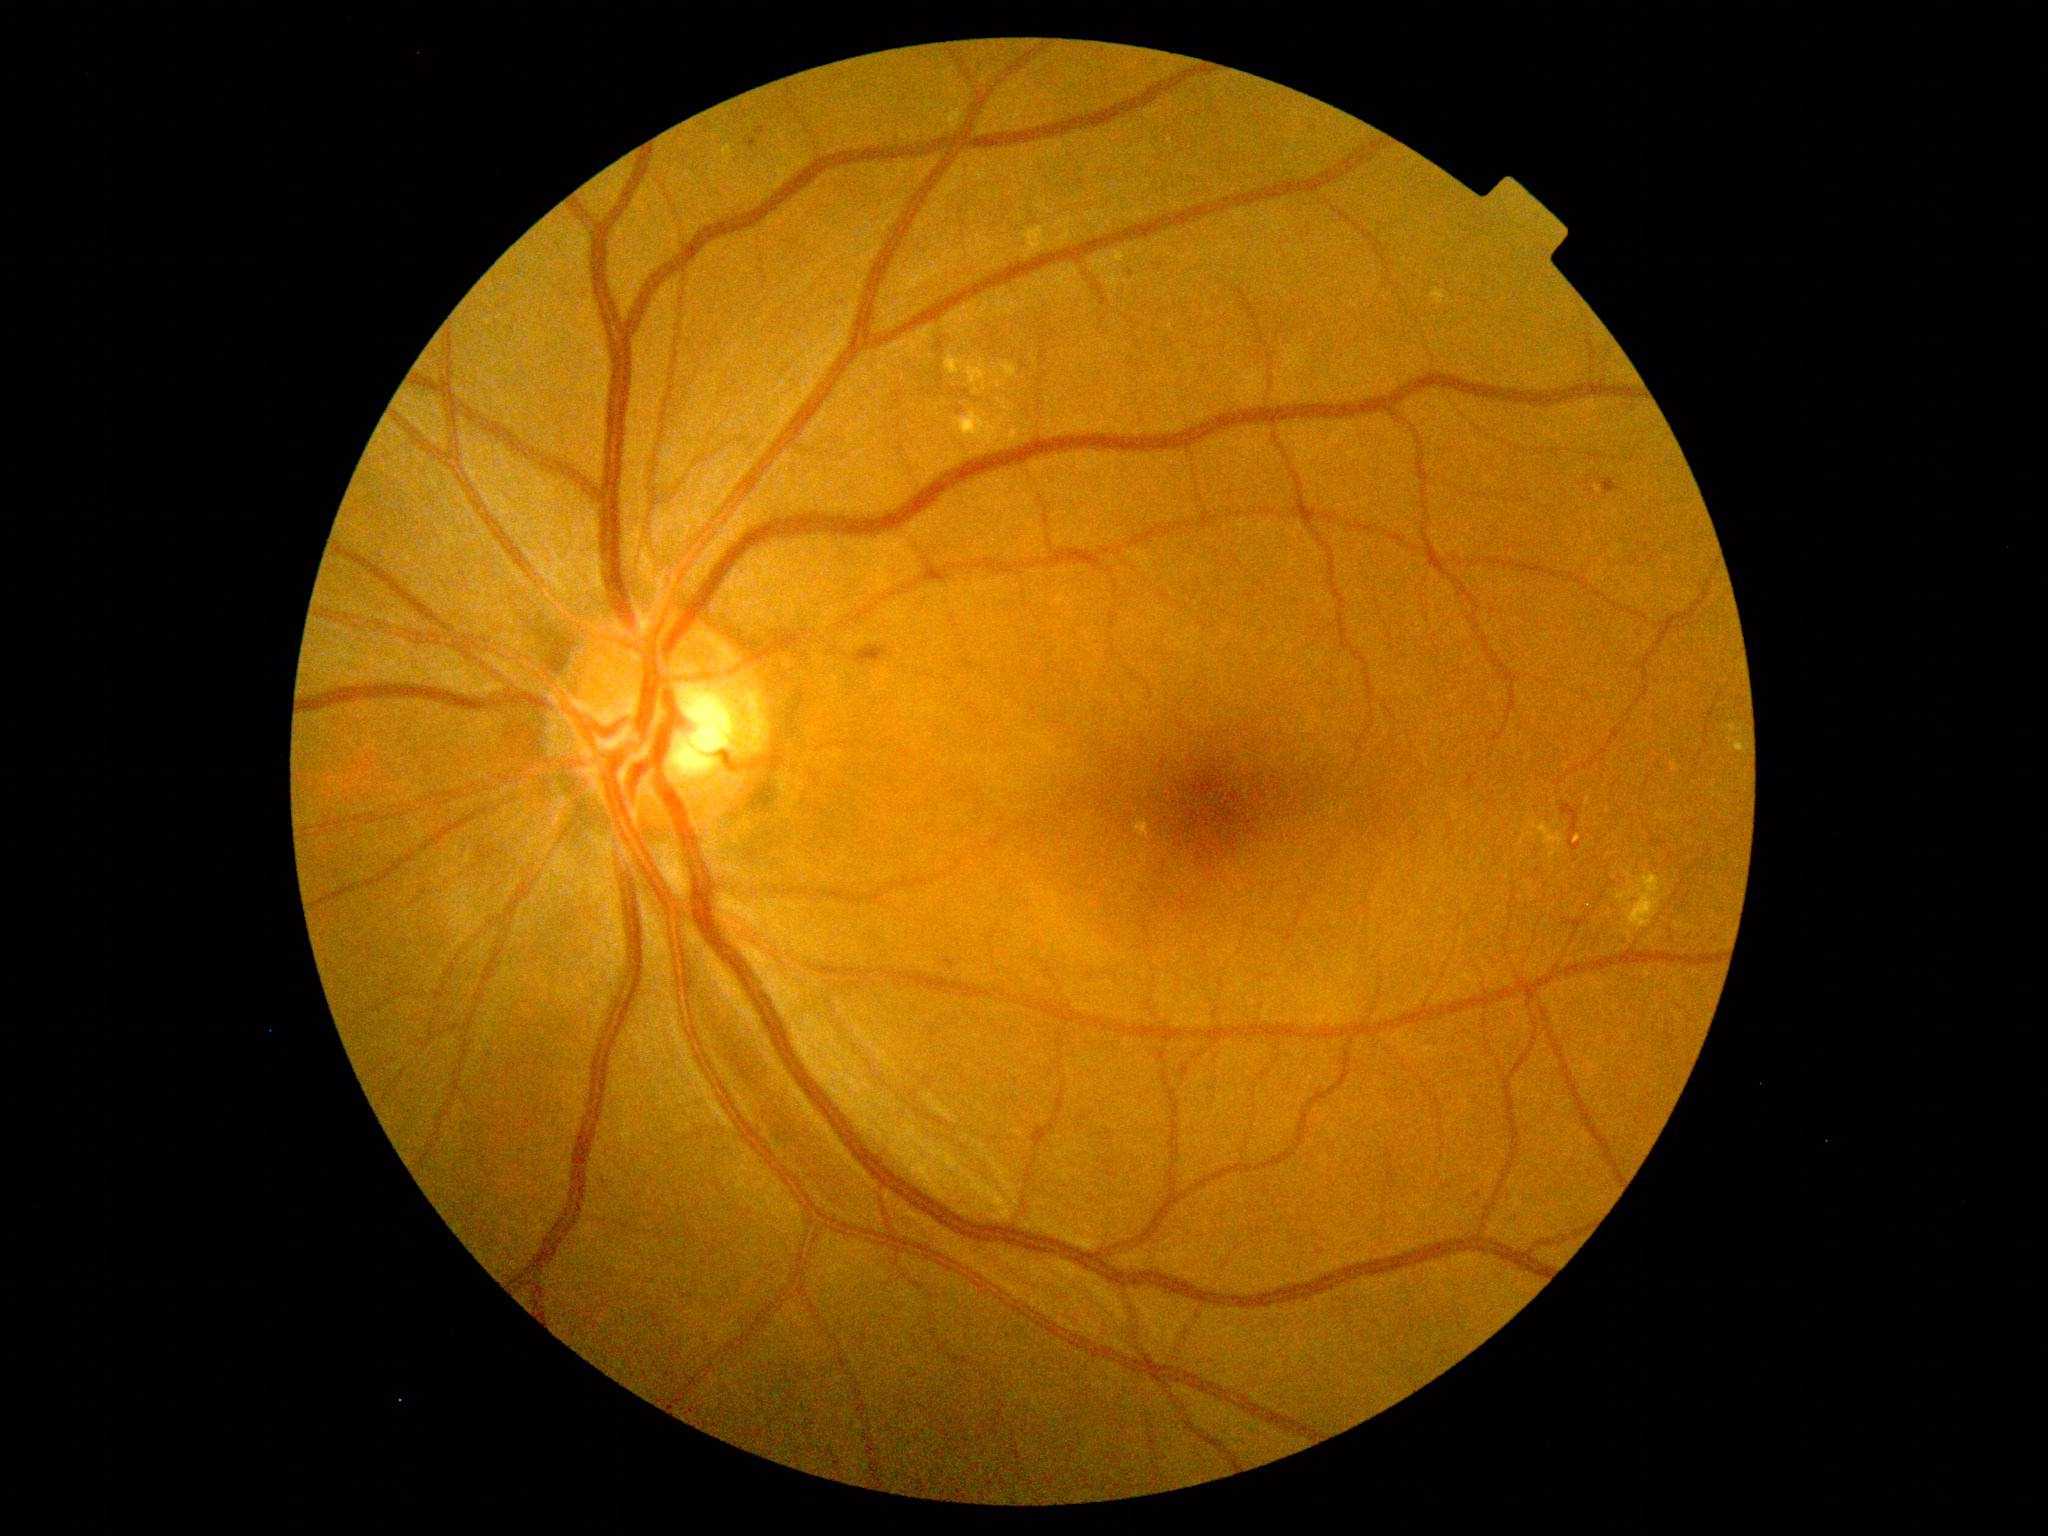 DR: grade 2 (moderate NPDR)
MAs: 755,127,765,136 | 745,139,757,149 | 1315,1252,1327,1257
Smaller MAs around [x=1479, y=1196] | [x=1131, y=275] | [x=1415, y=277]
EXs: 1134,819,1151,841 | 966,359,987,395 | 953,408,1010,455 | 724,146,734,165 | 946,354,964,375 | 1728,738,1748,753 | 1529,819,1566,863 | 1431,289,1446,305 | 1000,362,1019,379 | 1022,226,1052,259 | 1726,724,1744,733 | 1613,872,1668,931
SEs: none
HEs: 1599,478,1620,495 | 946,959,954,967 | 1562,805,1582,852 | 855,646,890,667